Fundus photo · 45° FOV · 2212 x 1659 pixels.
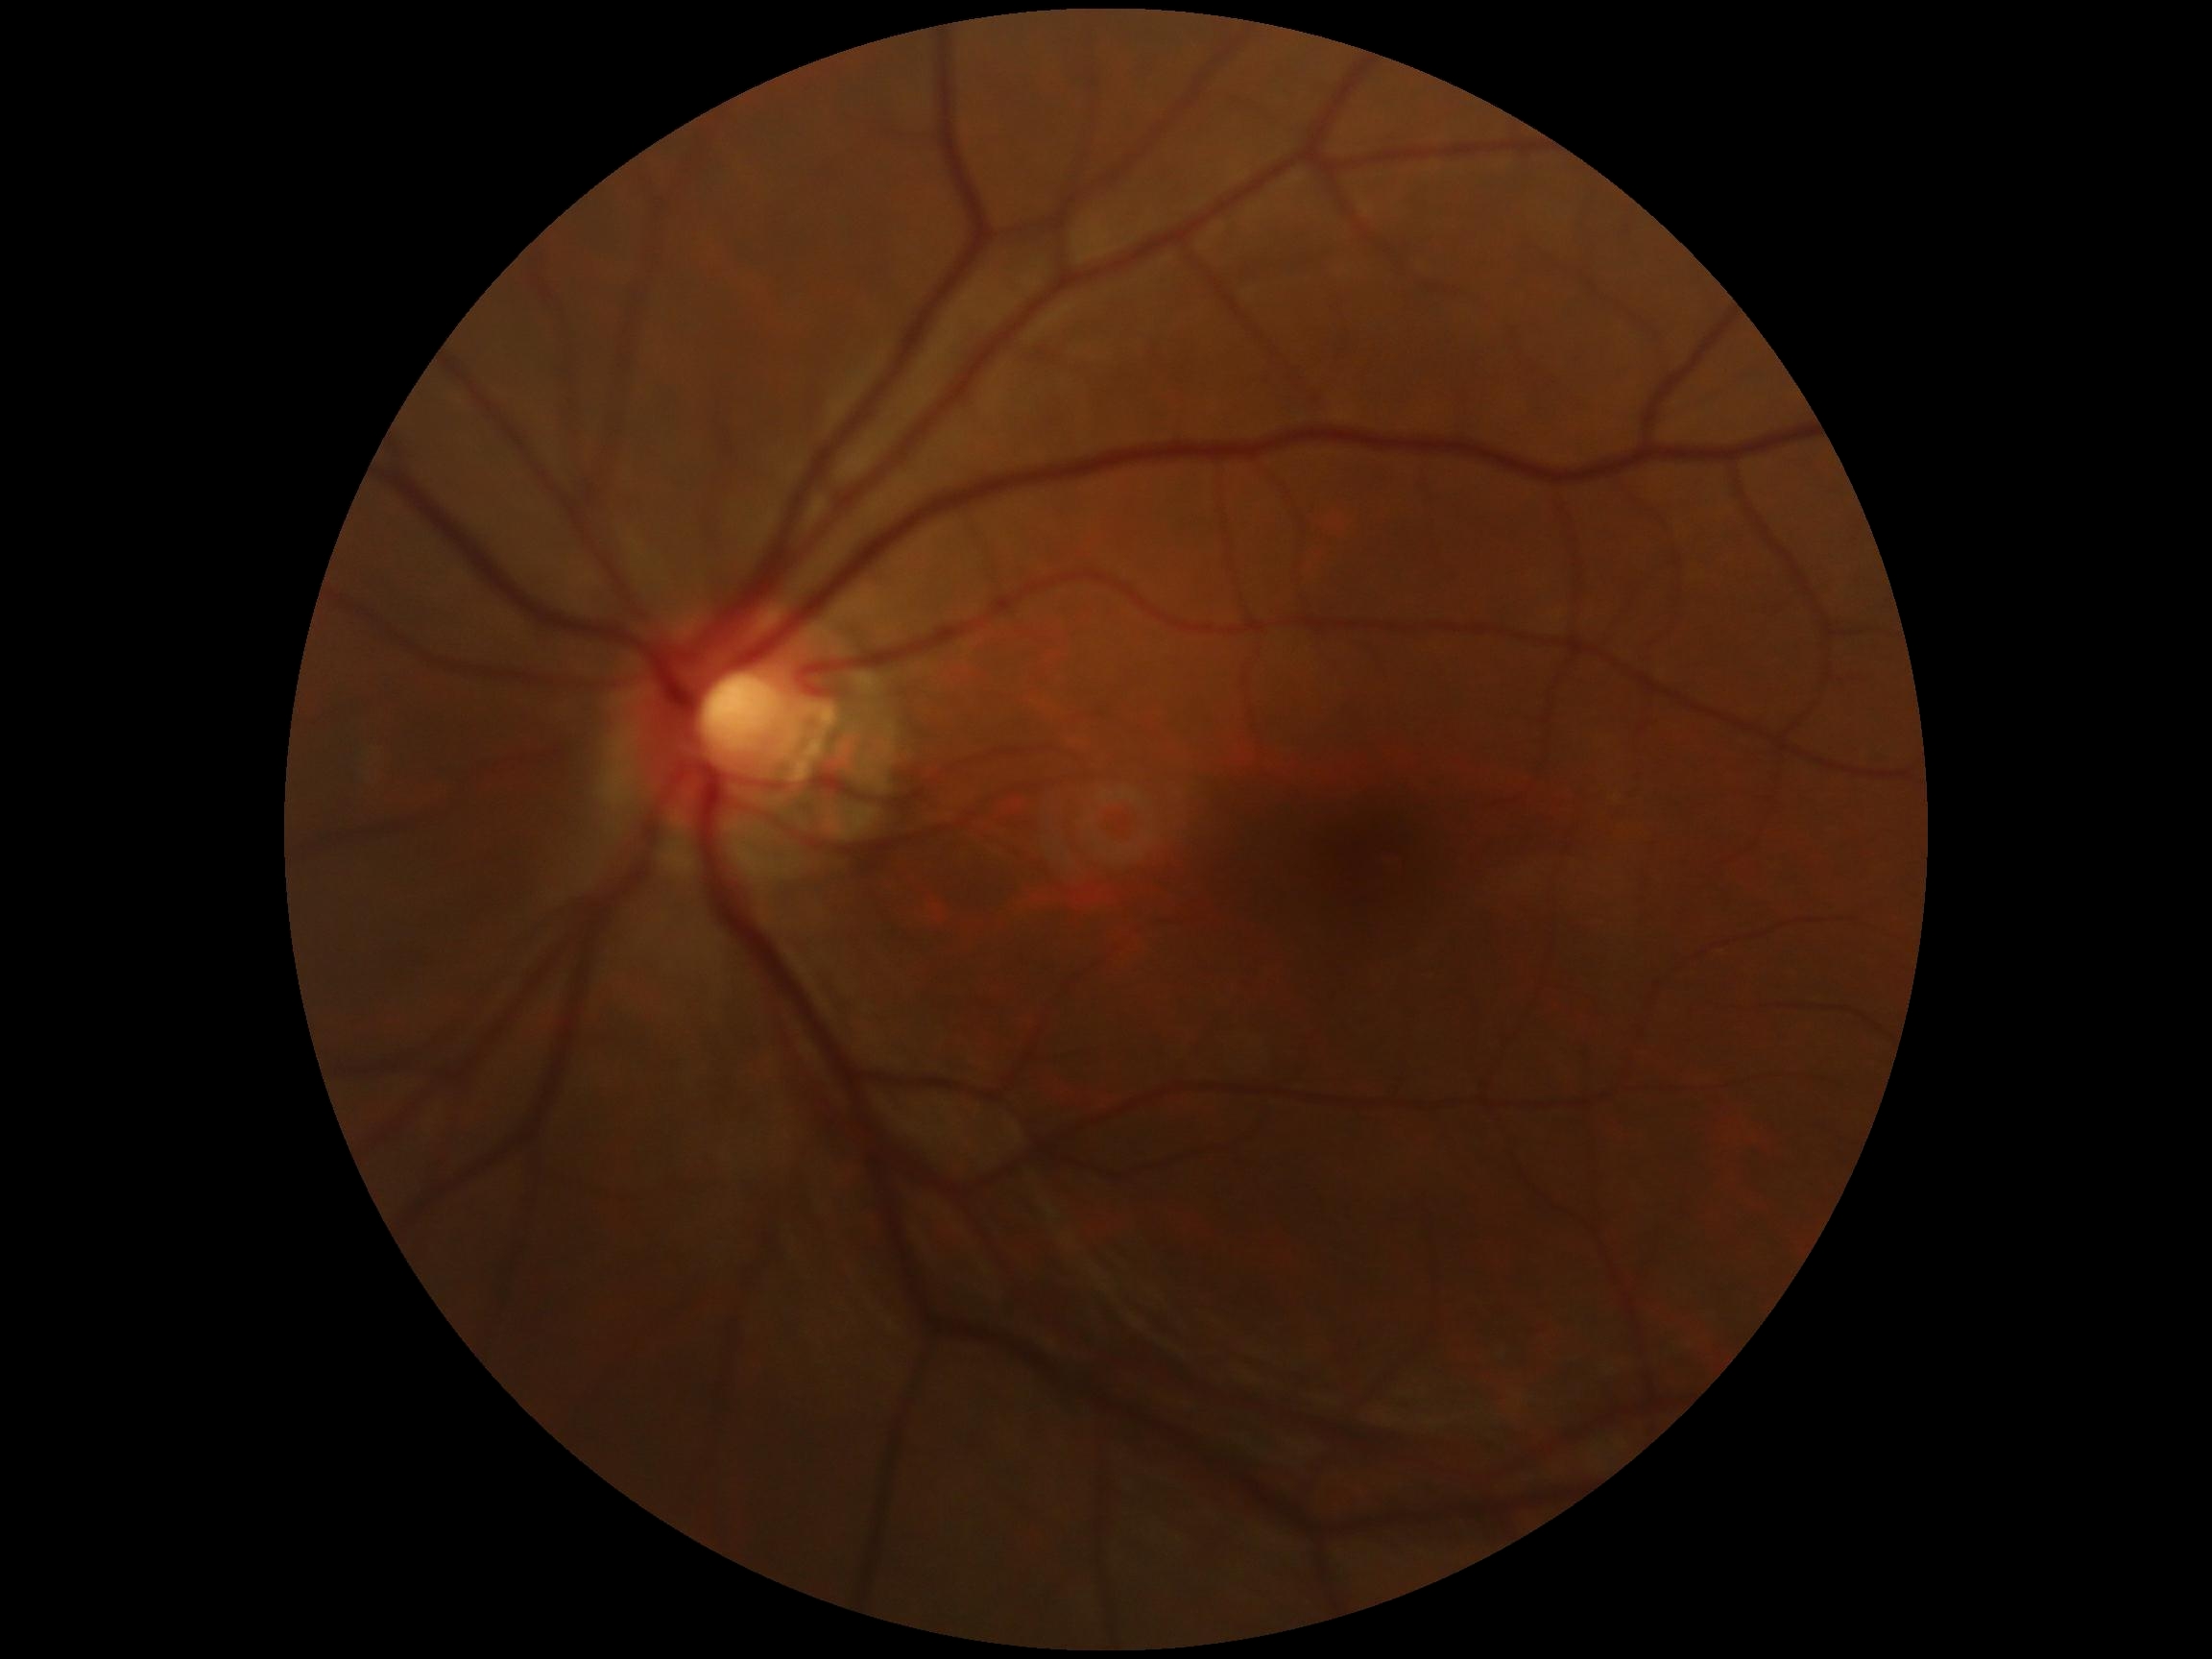
Diabetic retinopathy severity: grade 0 (no apparent retinopathy). No diabetic retinal disease findings.